Color fundus photograph
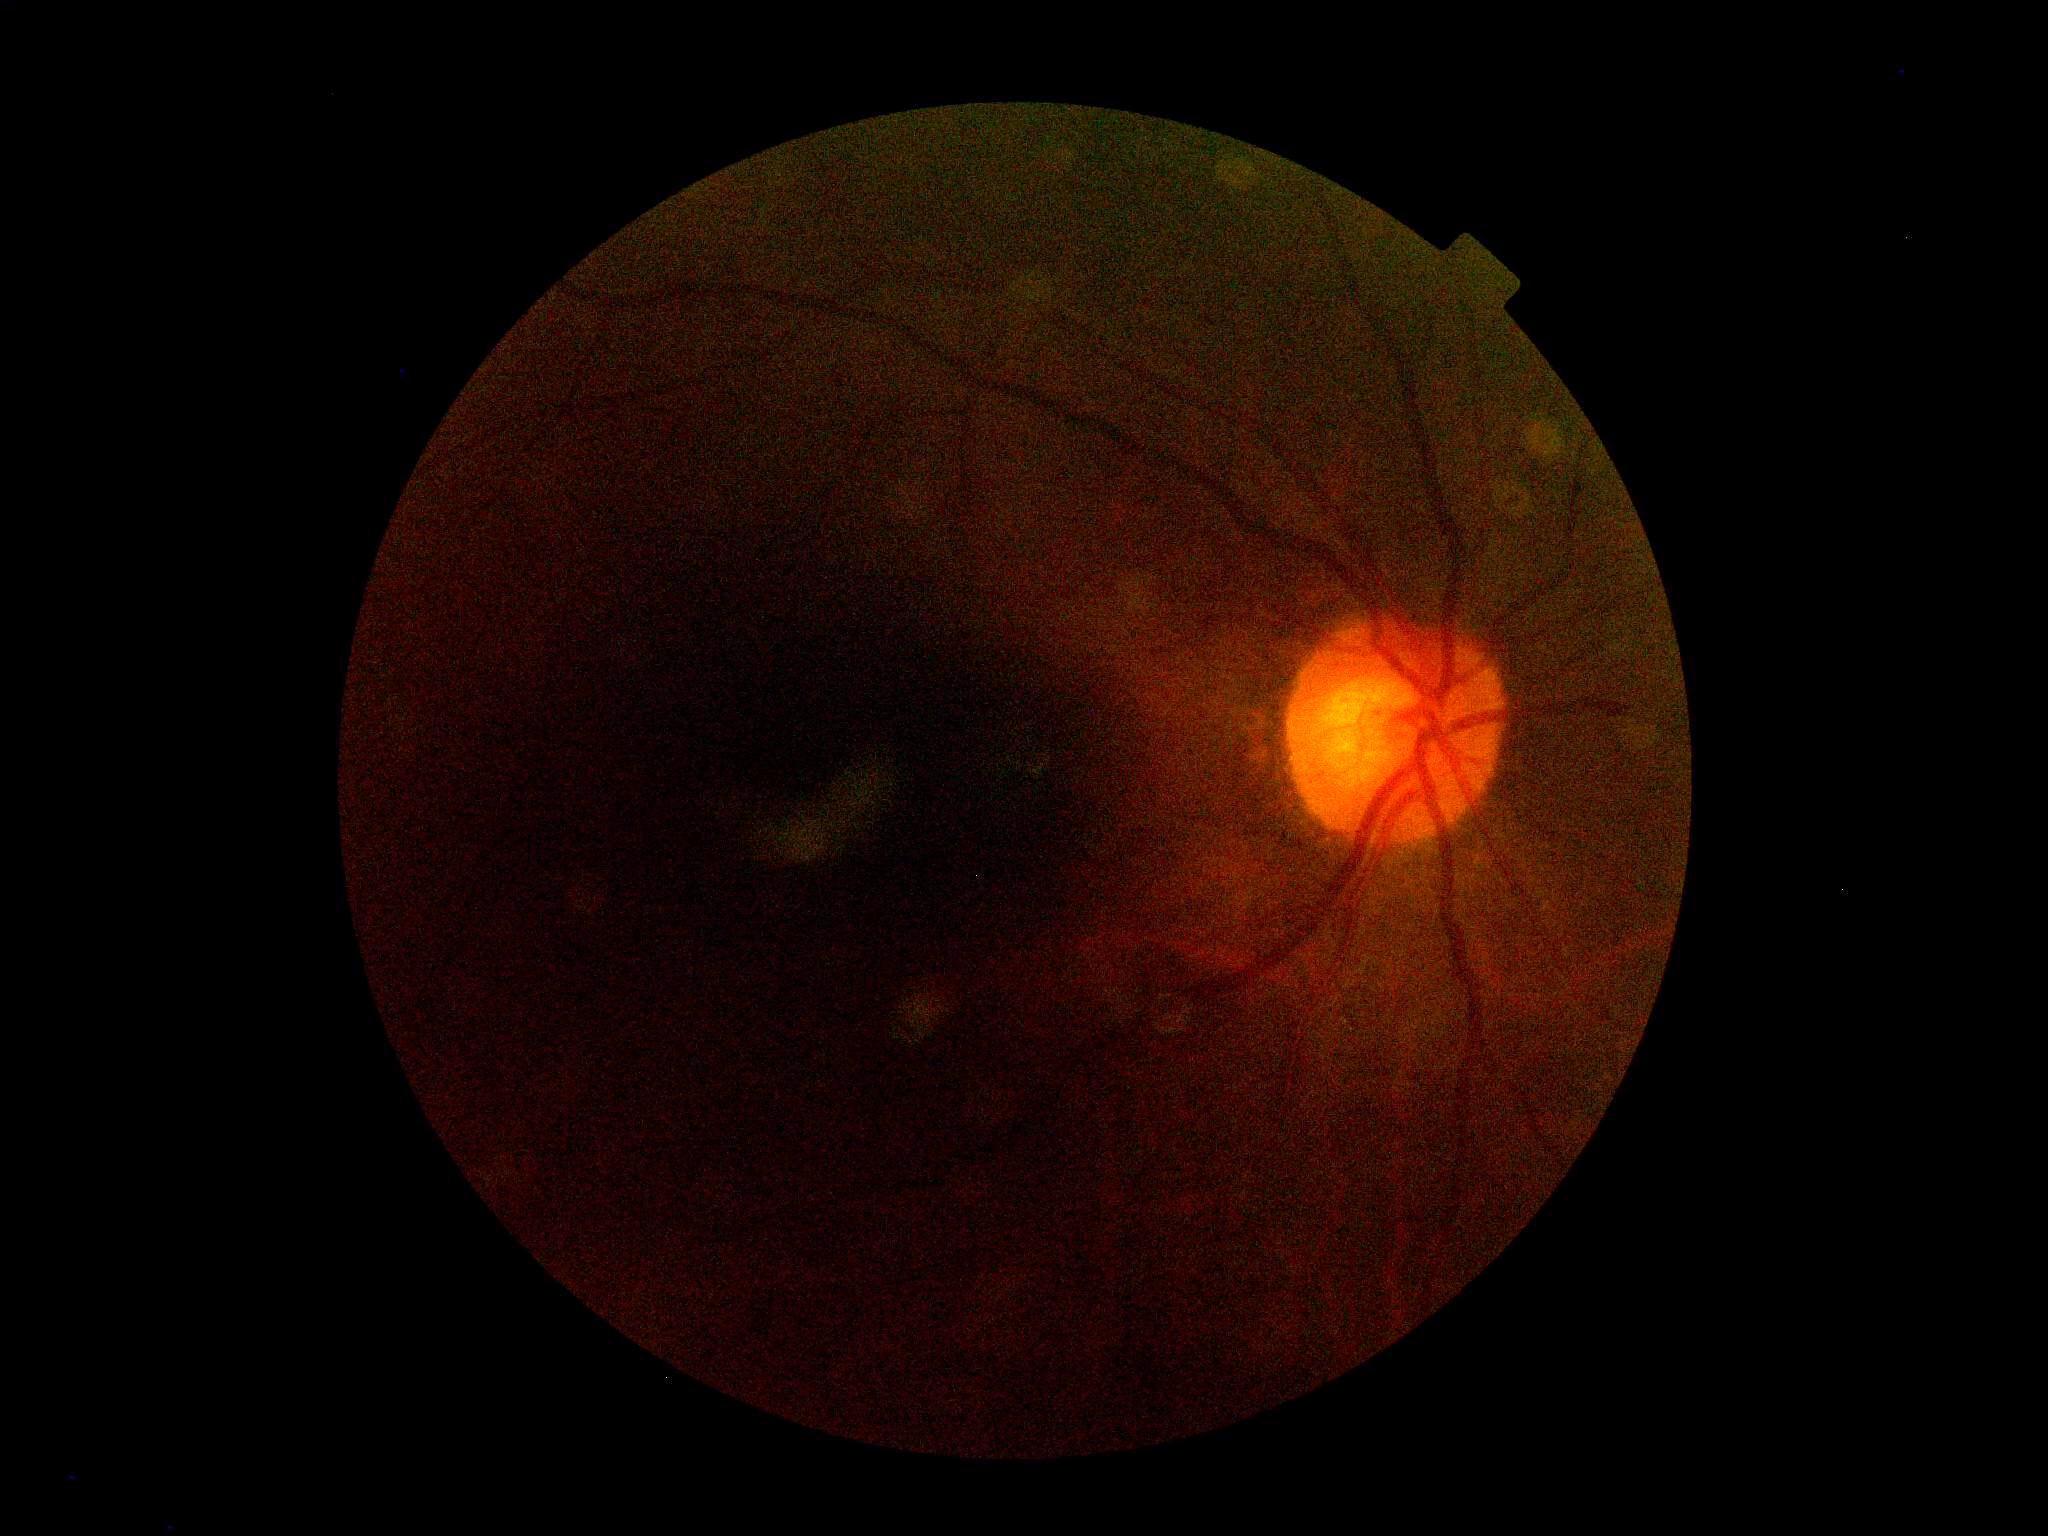 {"dr_grade": "ungradable due to poor image quality"}